DR severity per modified Davis staging:
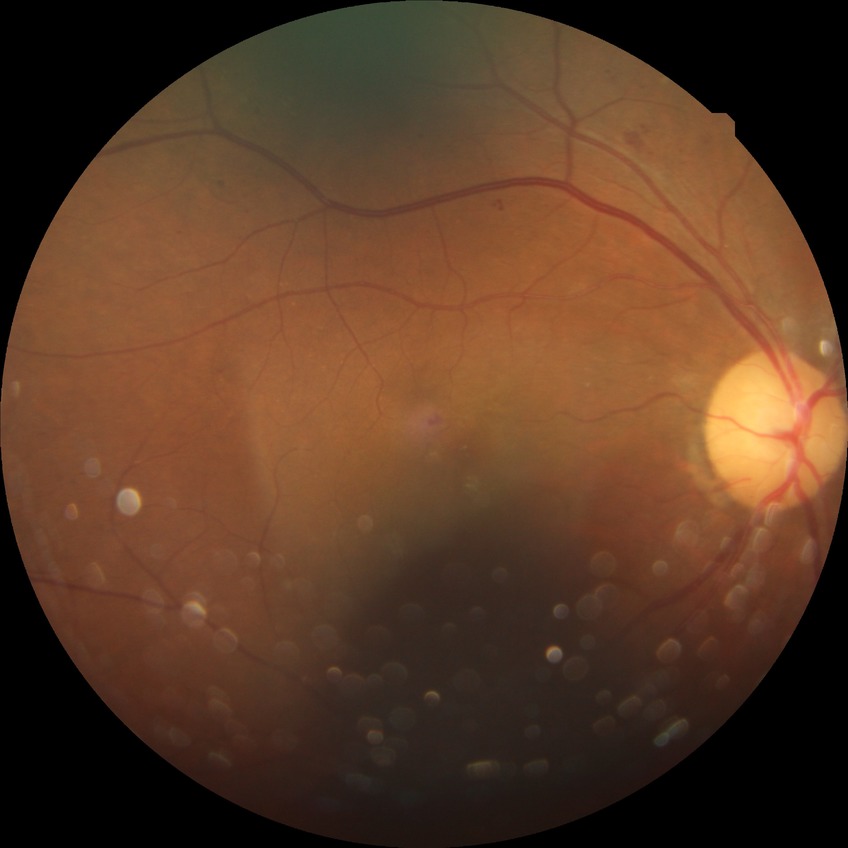 modified Davis grade: SDR.